45° FOV. 2352 by 1568 pixels:
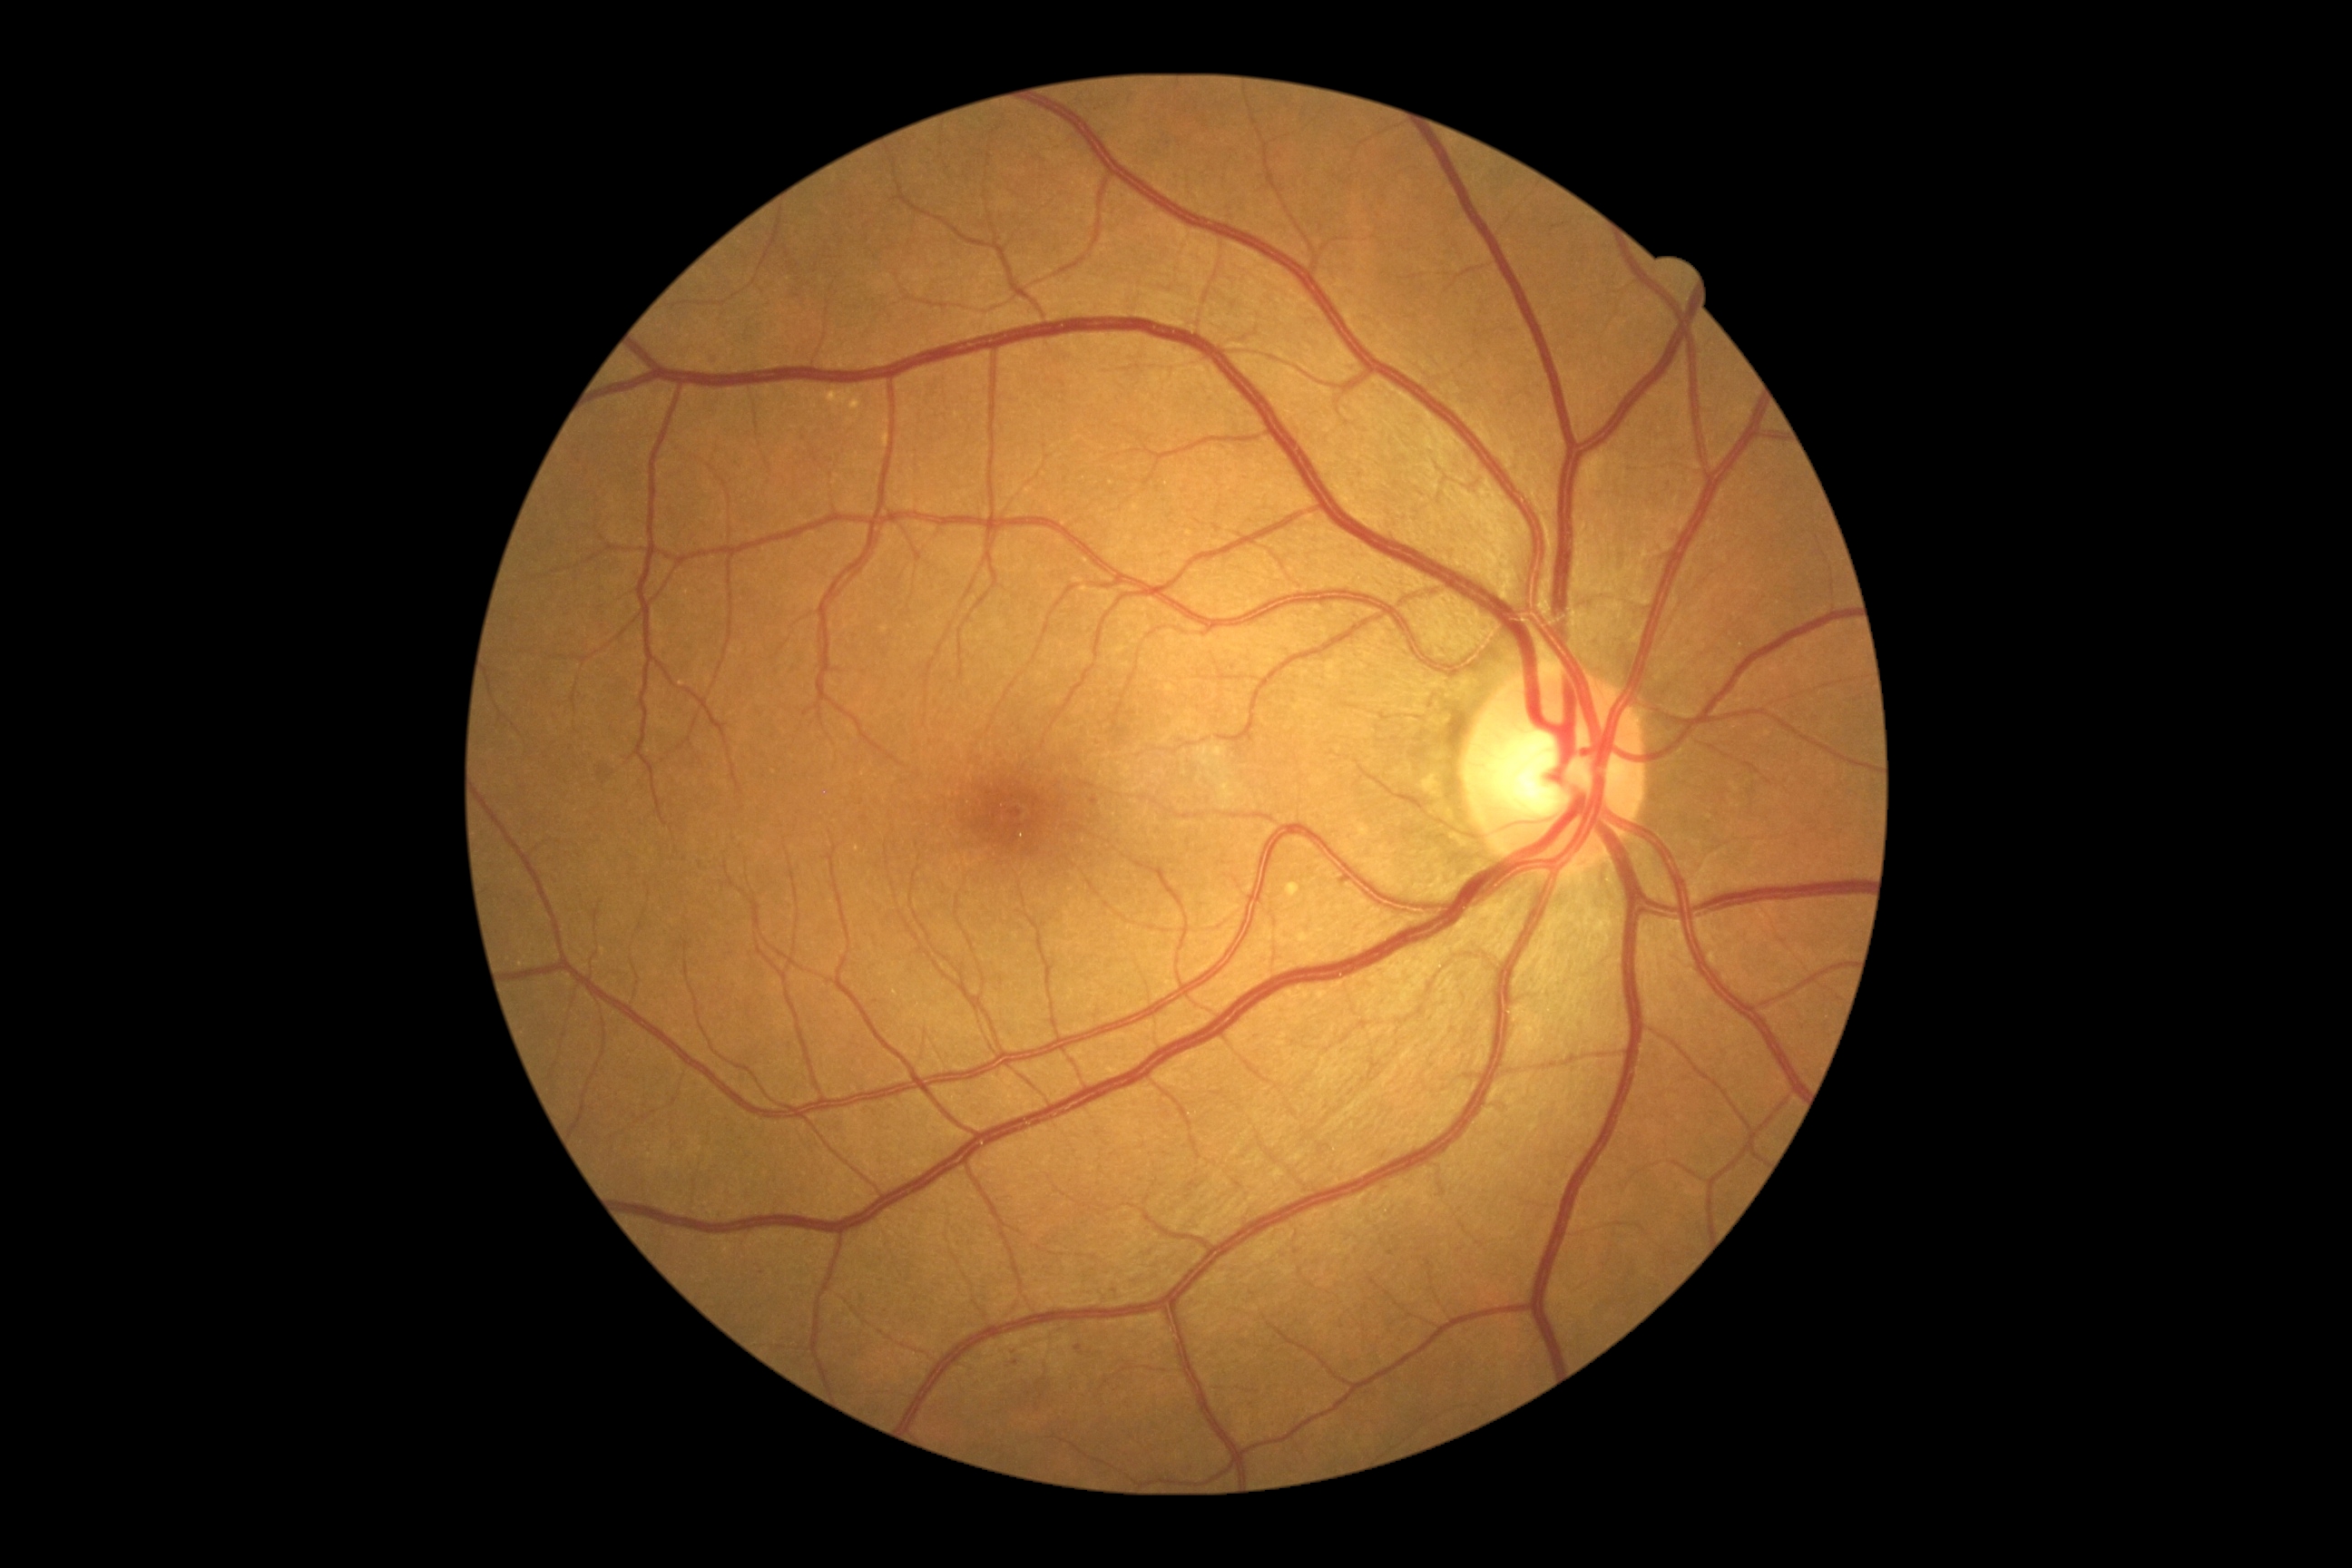 DR grade: mild NPDR (1) — presence of microaneurysms only. MAs present at 1092,798,1099,807. No HEs identified. No SEs identified. EXs present at 1286,883,1300,899.